Phoenix ICON, 100° FOV; infant wide-field fundus photograph: 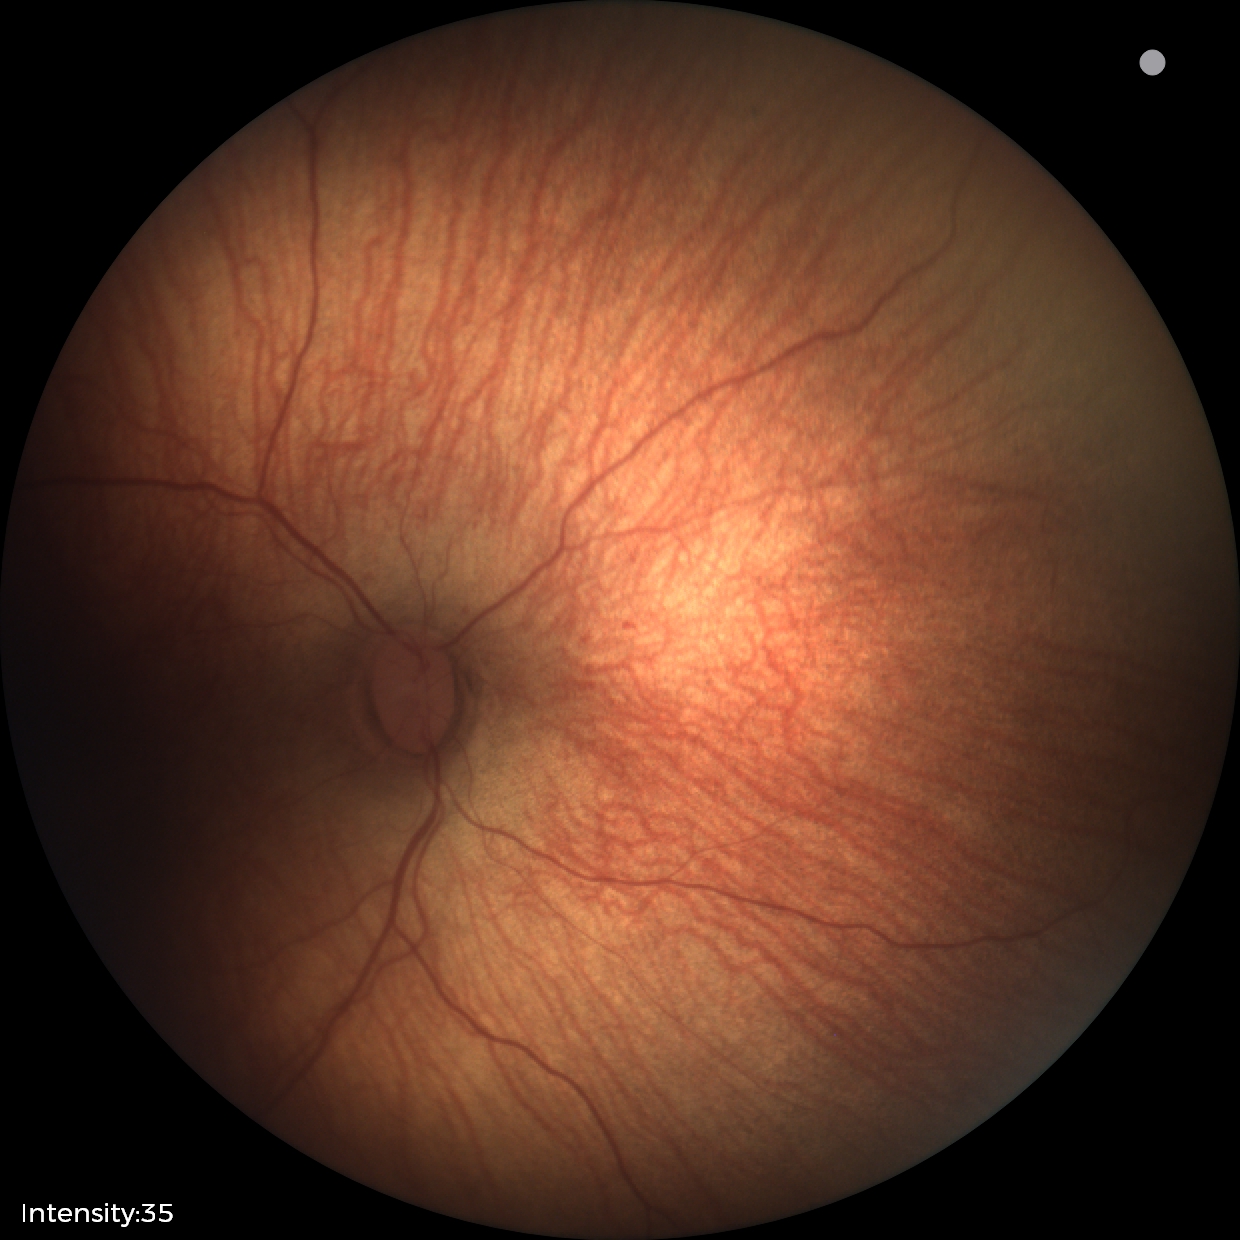

Screening series with status post retinopathy of prematurity. Plus disease absent.